Retinal fundus photograph:
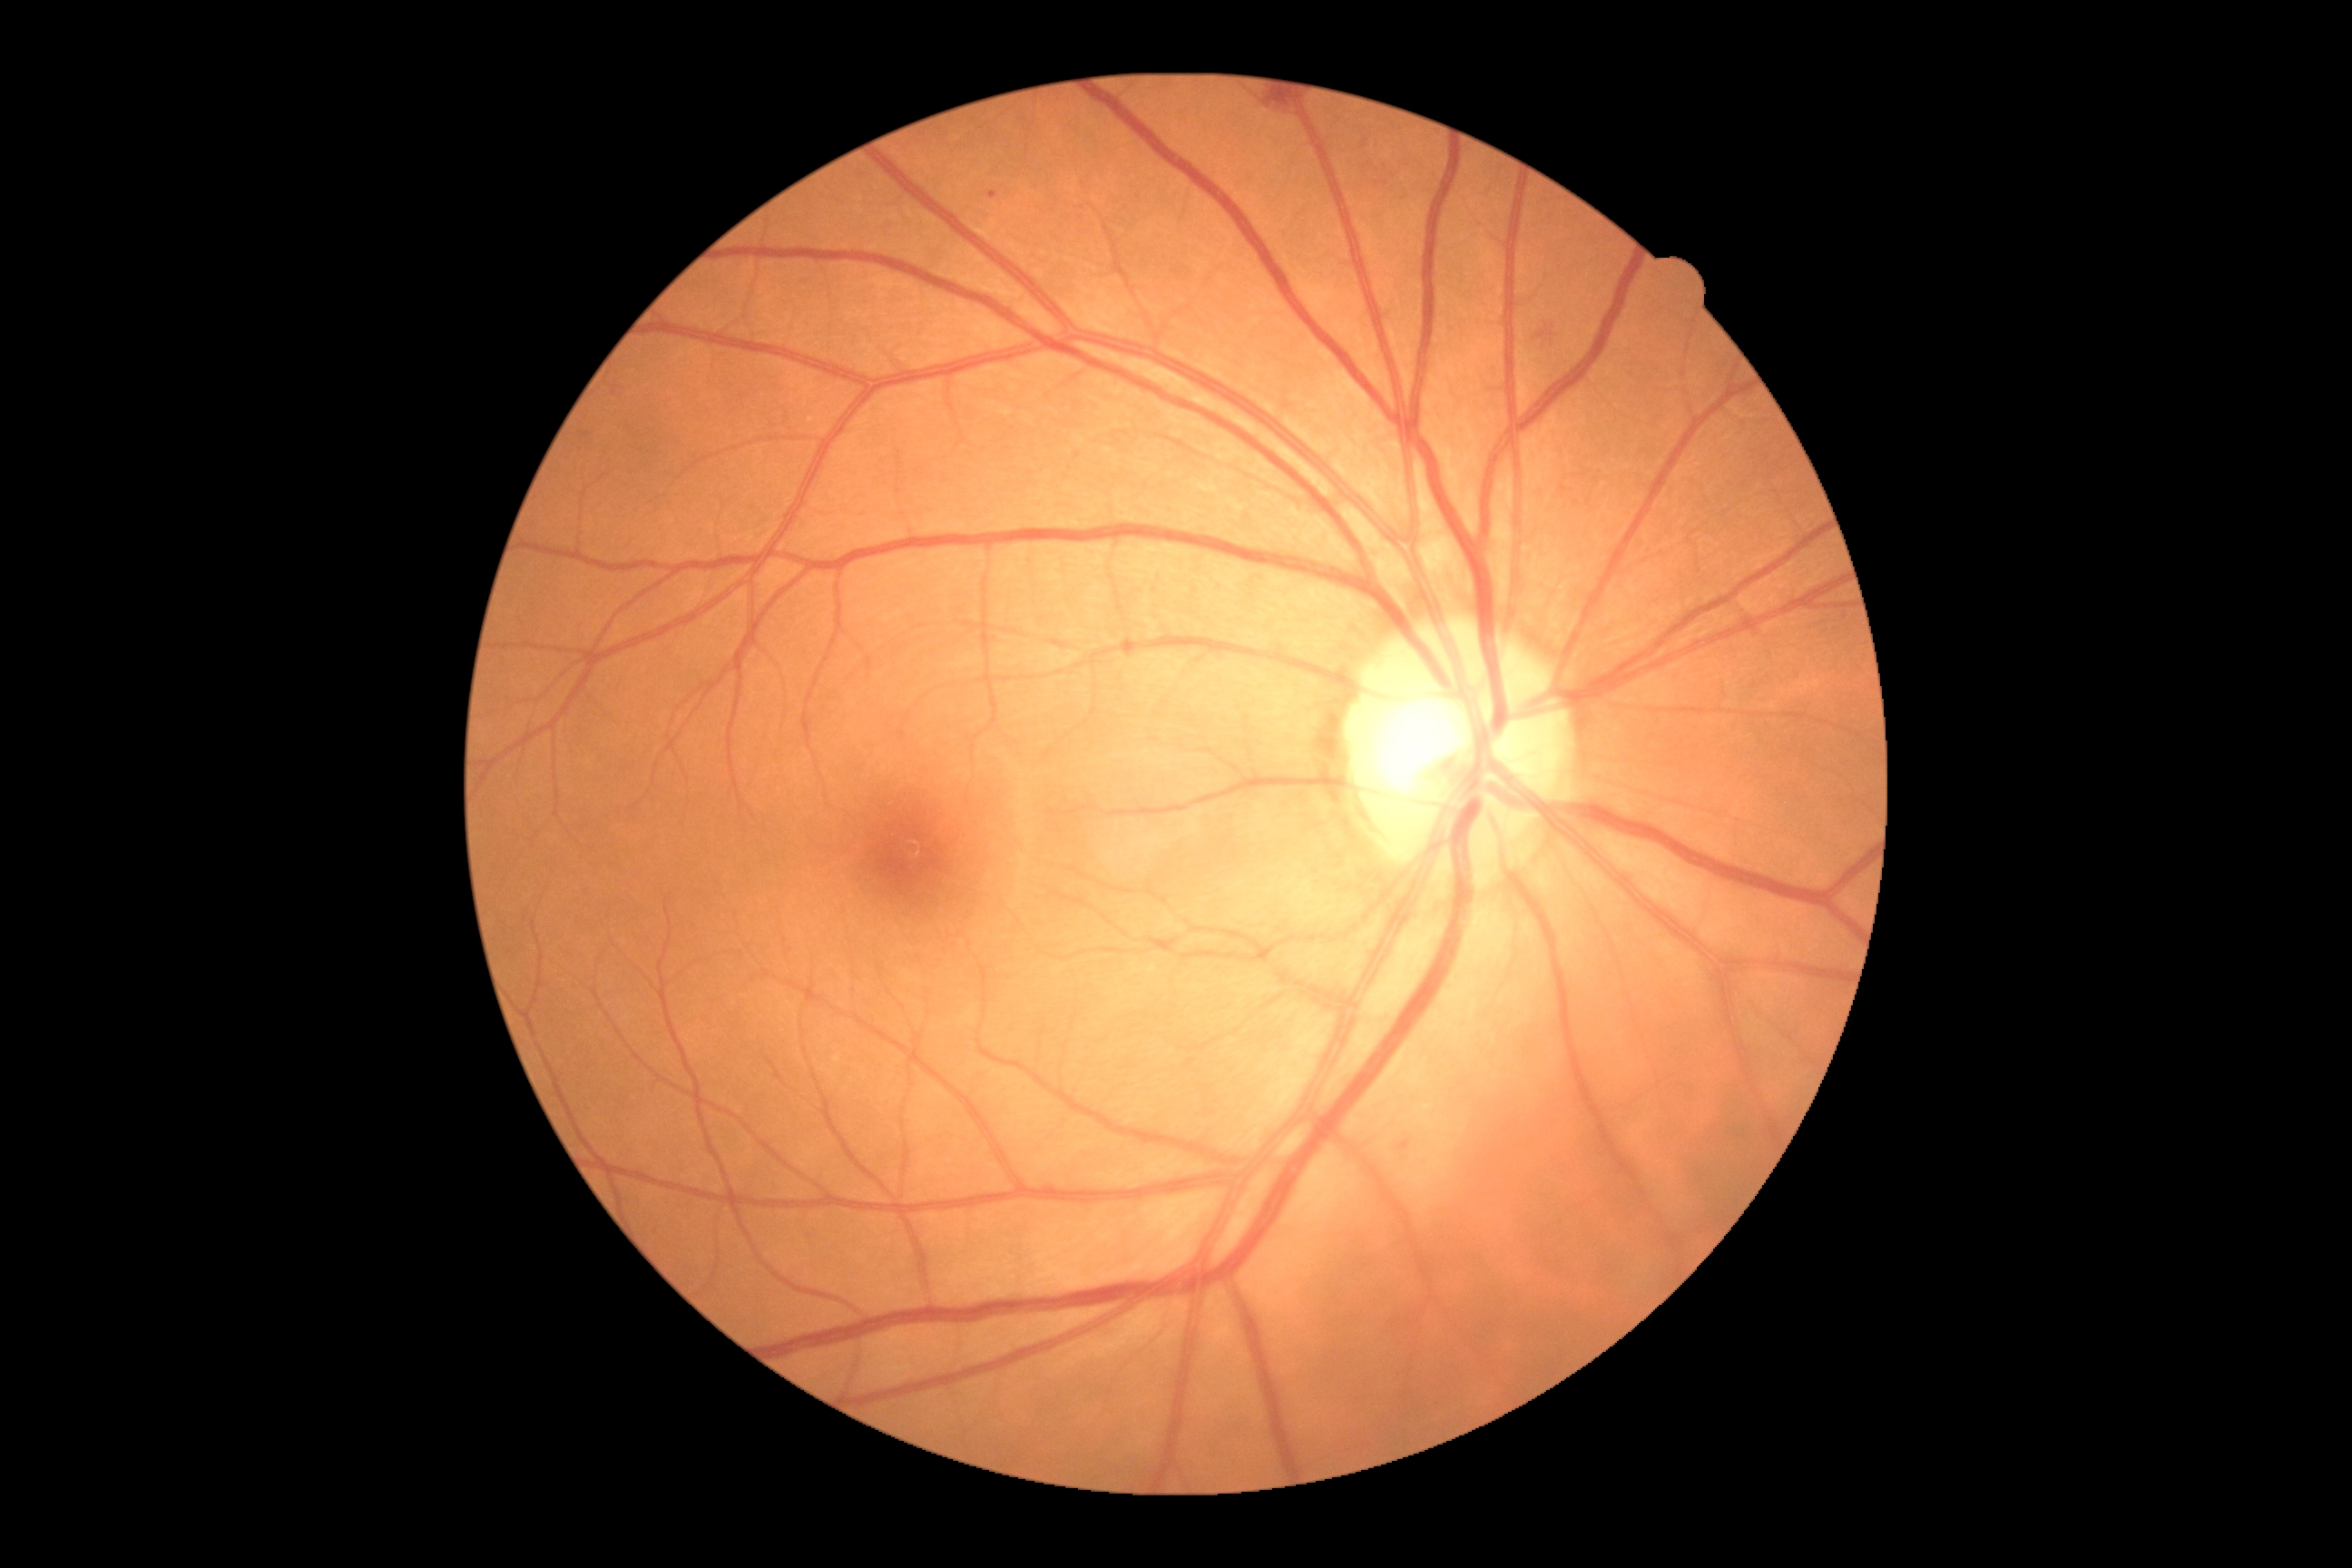

Annotations:
* diabetic retinopathy (DR) — moderate NPDR (grade 2)
* DR class — non-proliferative diabetic retinopathy